45-degree field of view: 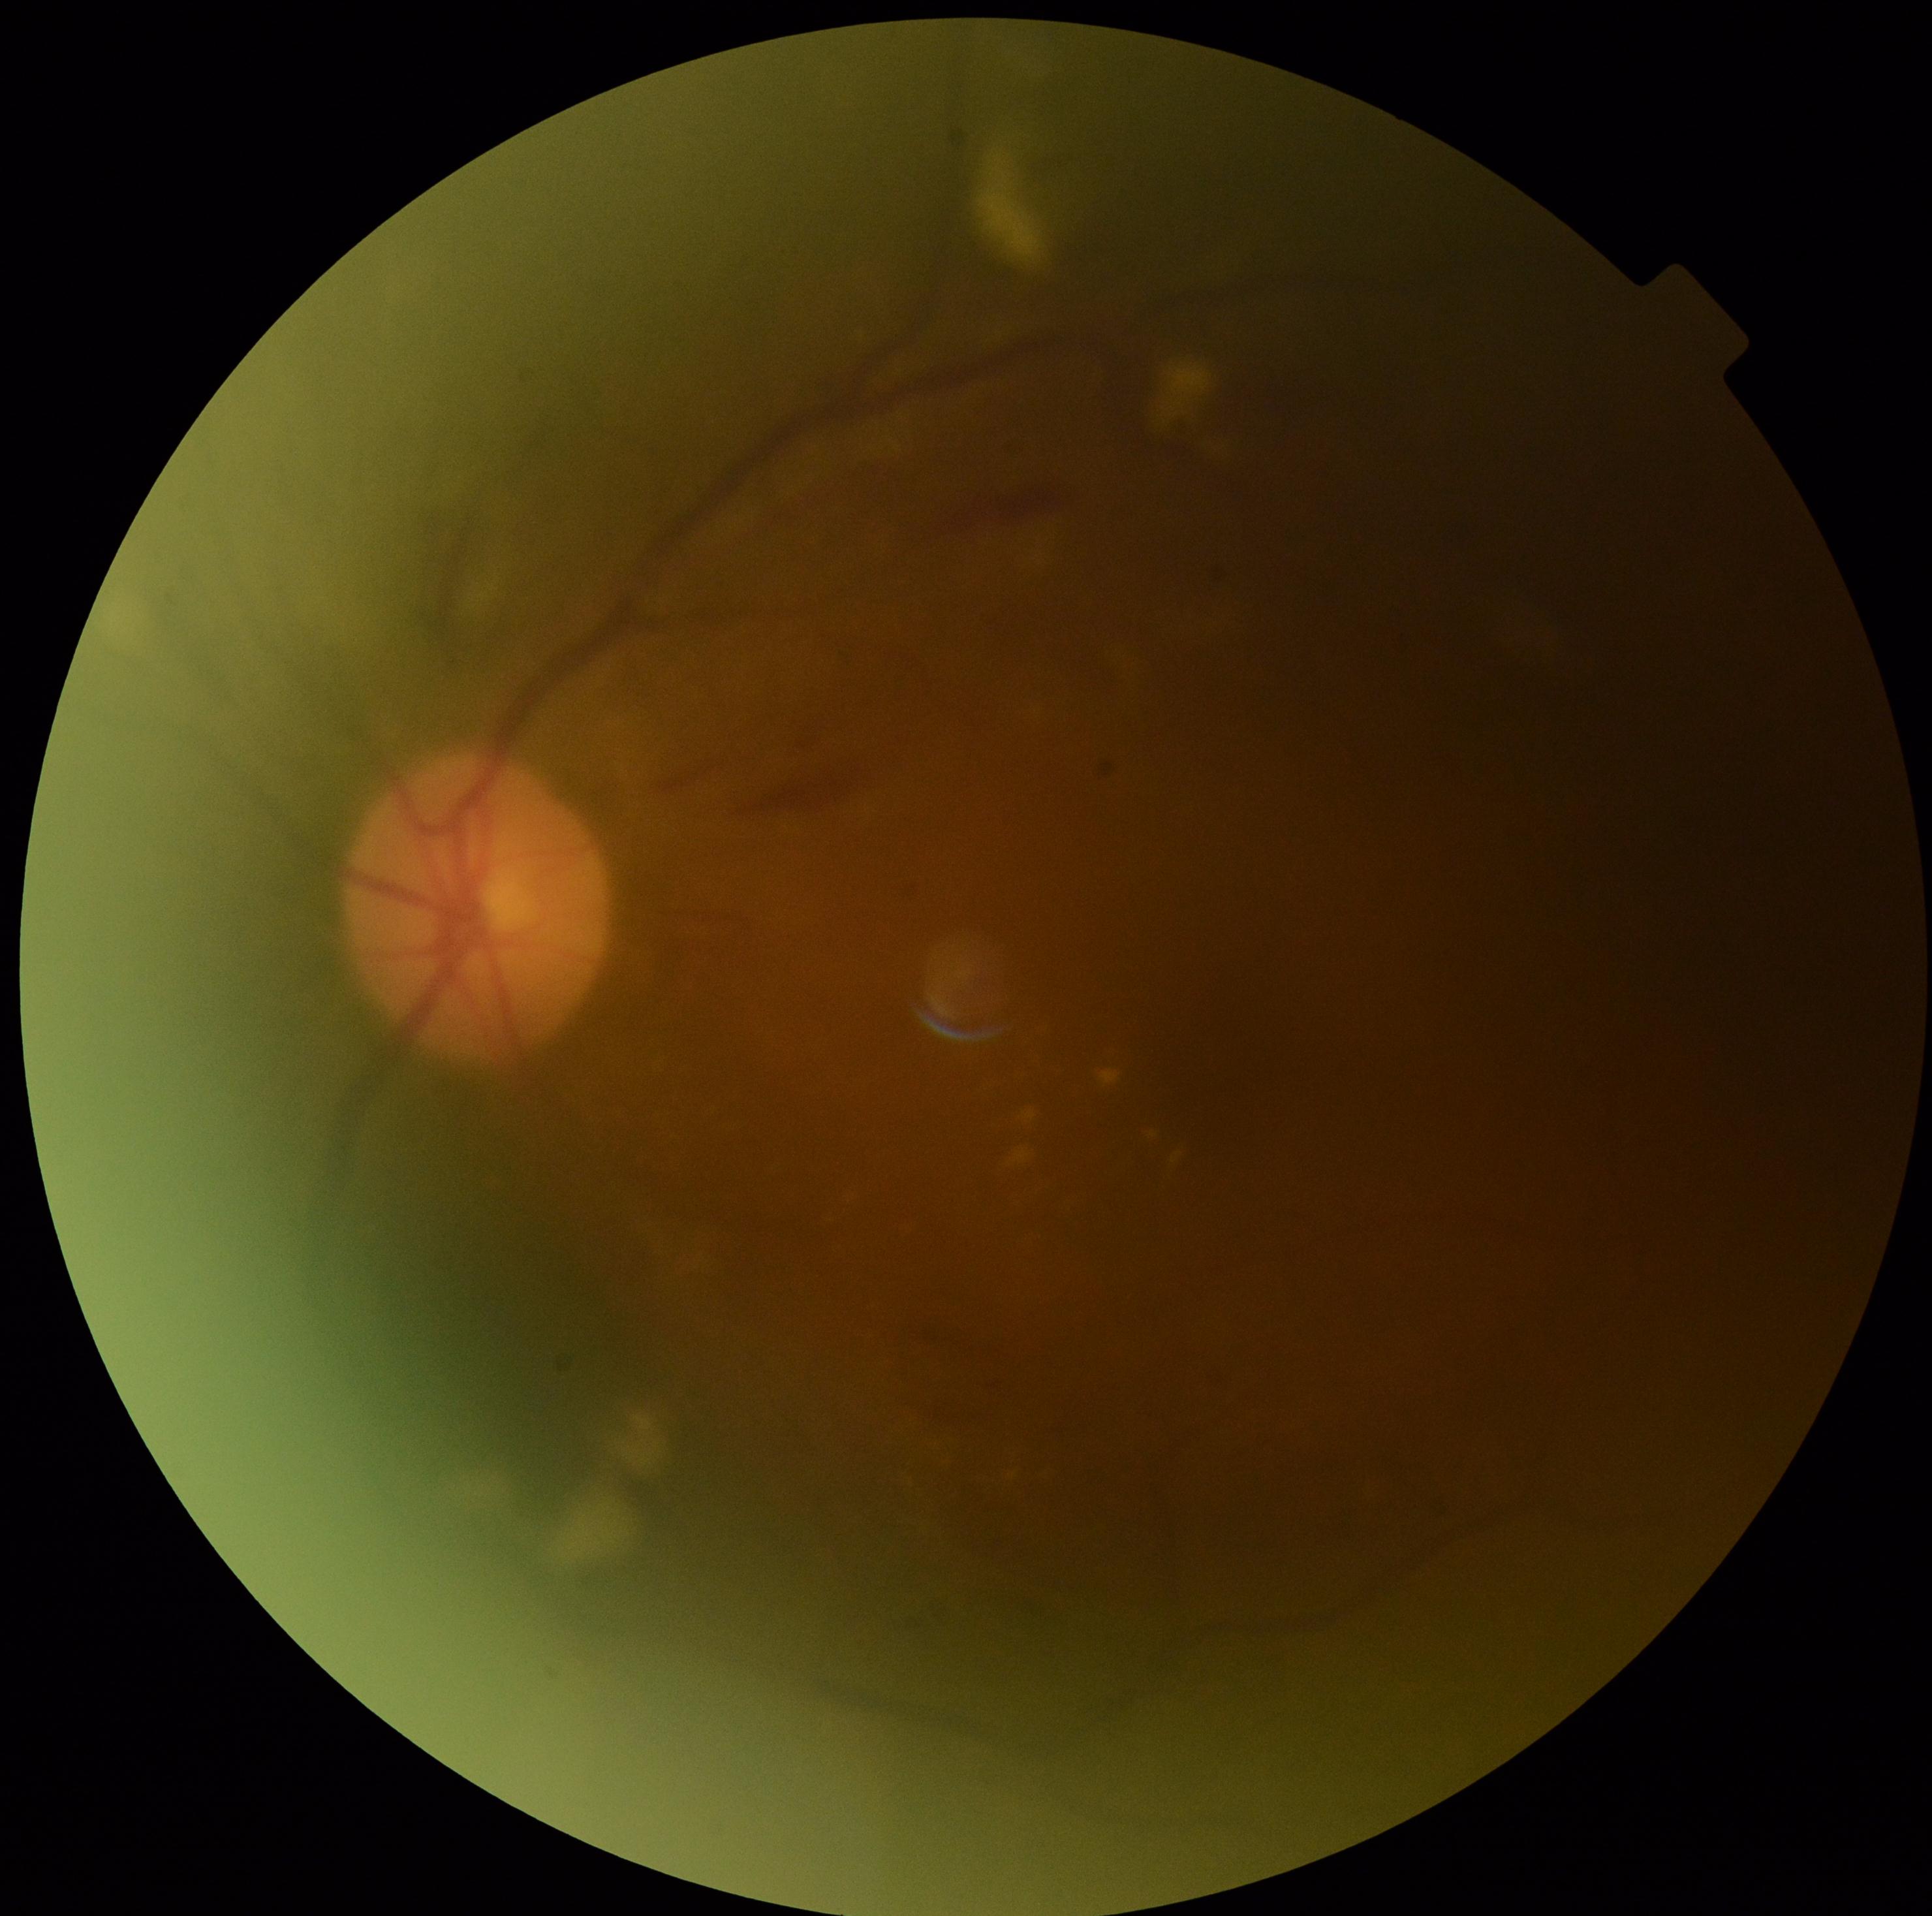

DR severity = grade 2.